Bosch handheld fundus camera: 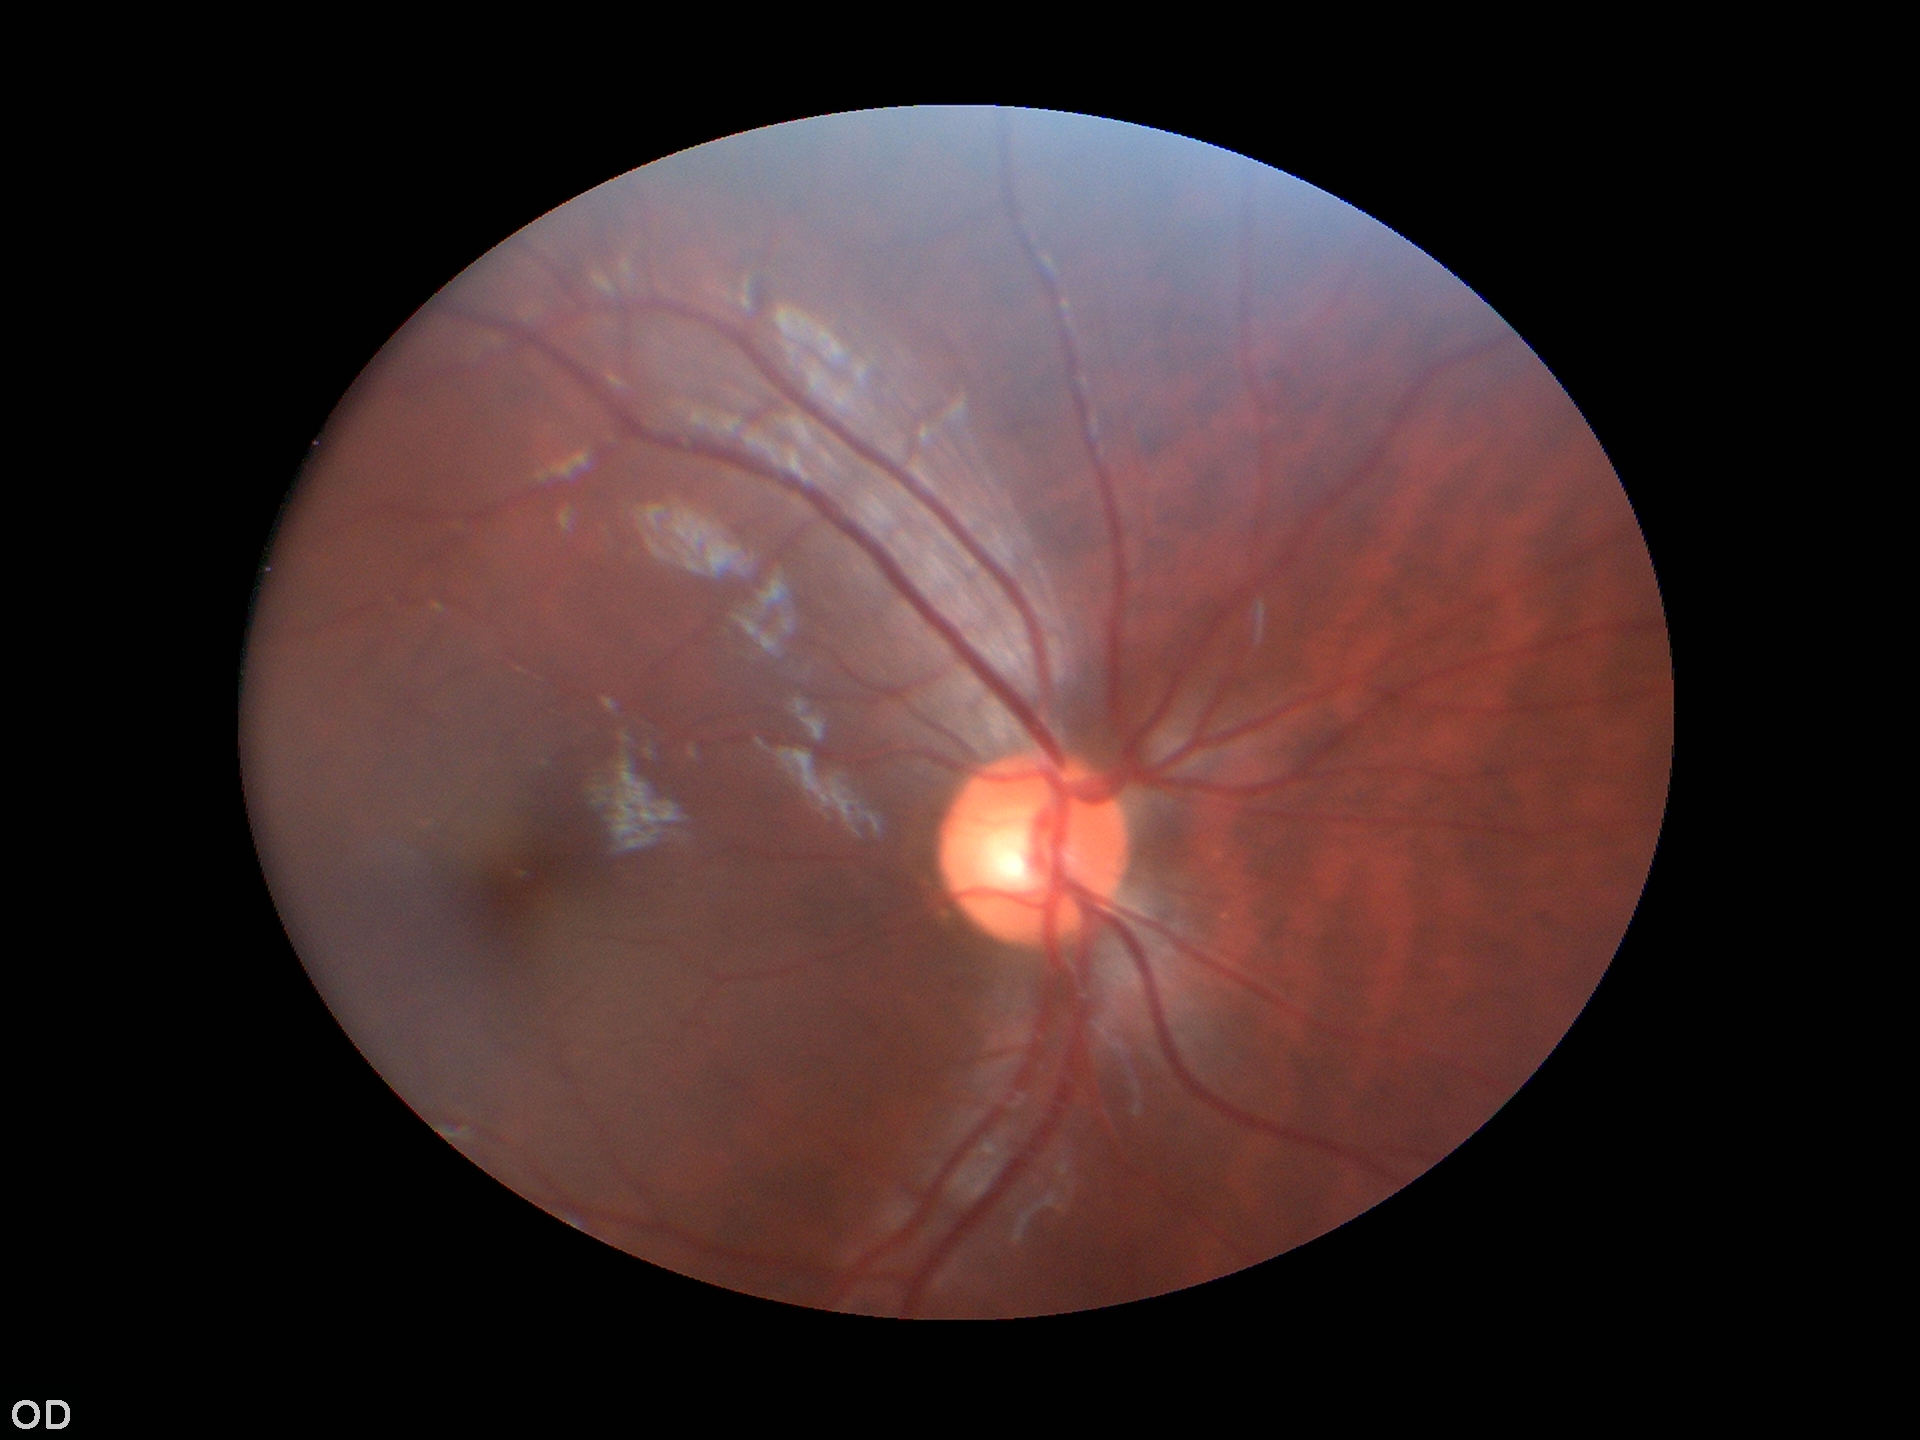

Vertical cup-disc ratio: 0.52. Not suspicious for glaucoma (5/5 ophthalmologists in agreement).